Phoenix ICON wide-field infant fundus image — 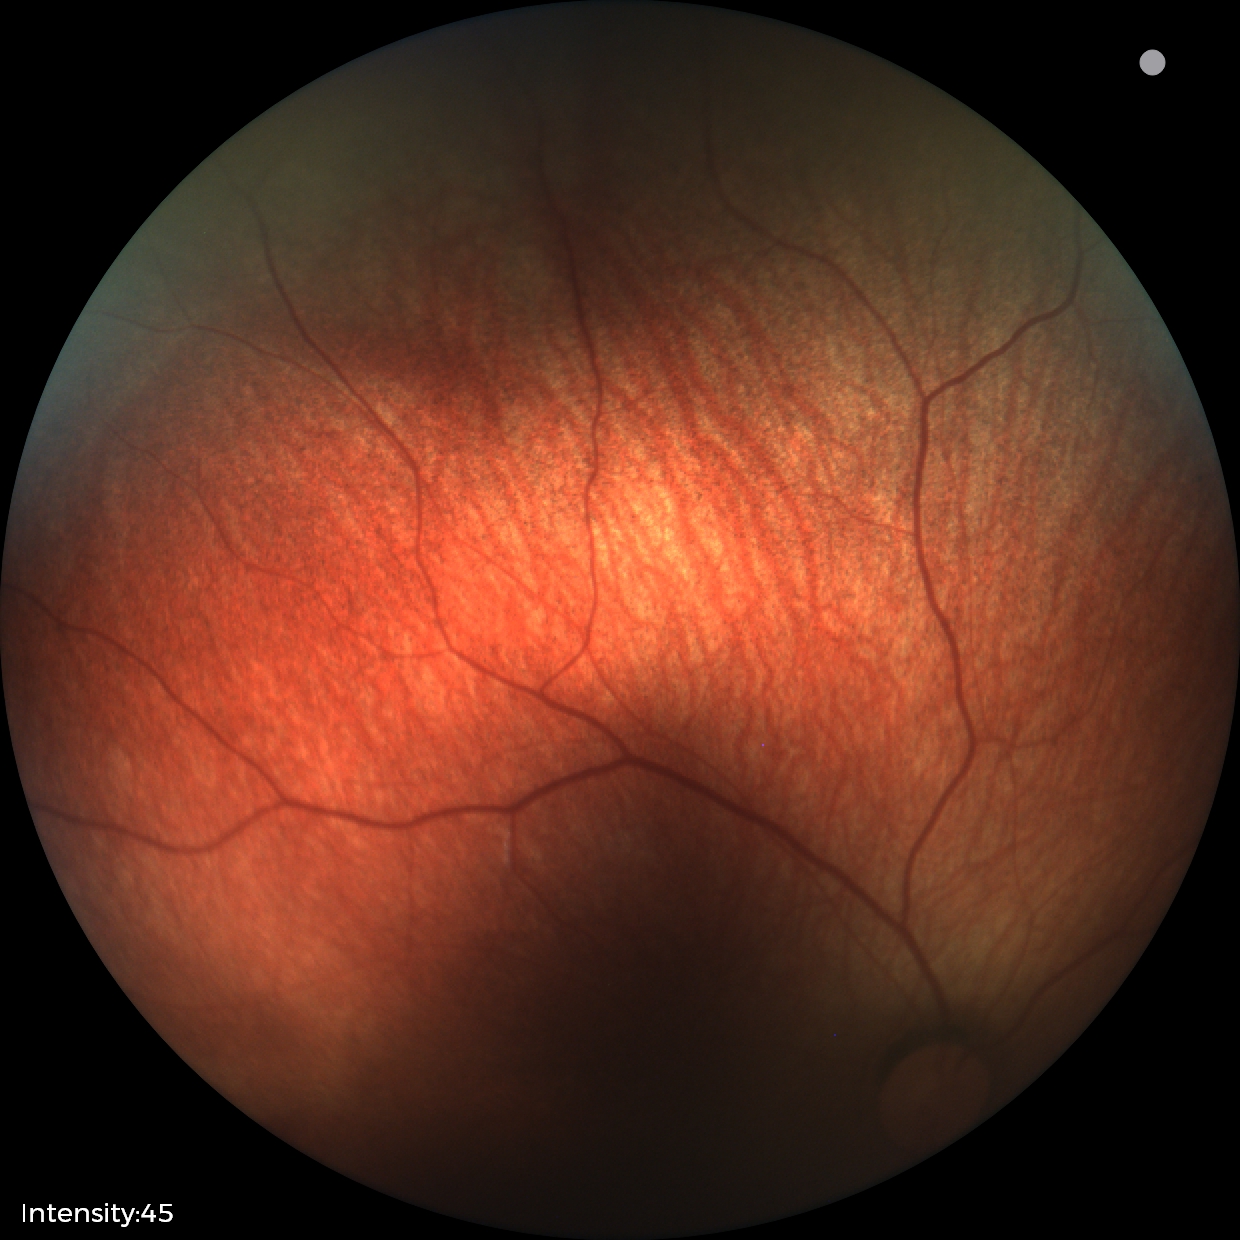 Impression = no abnormalities.